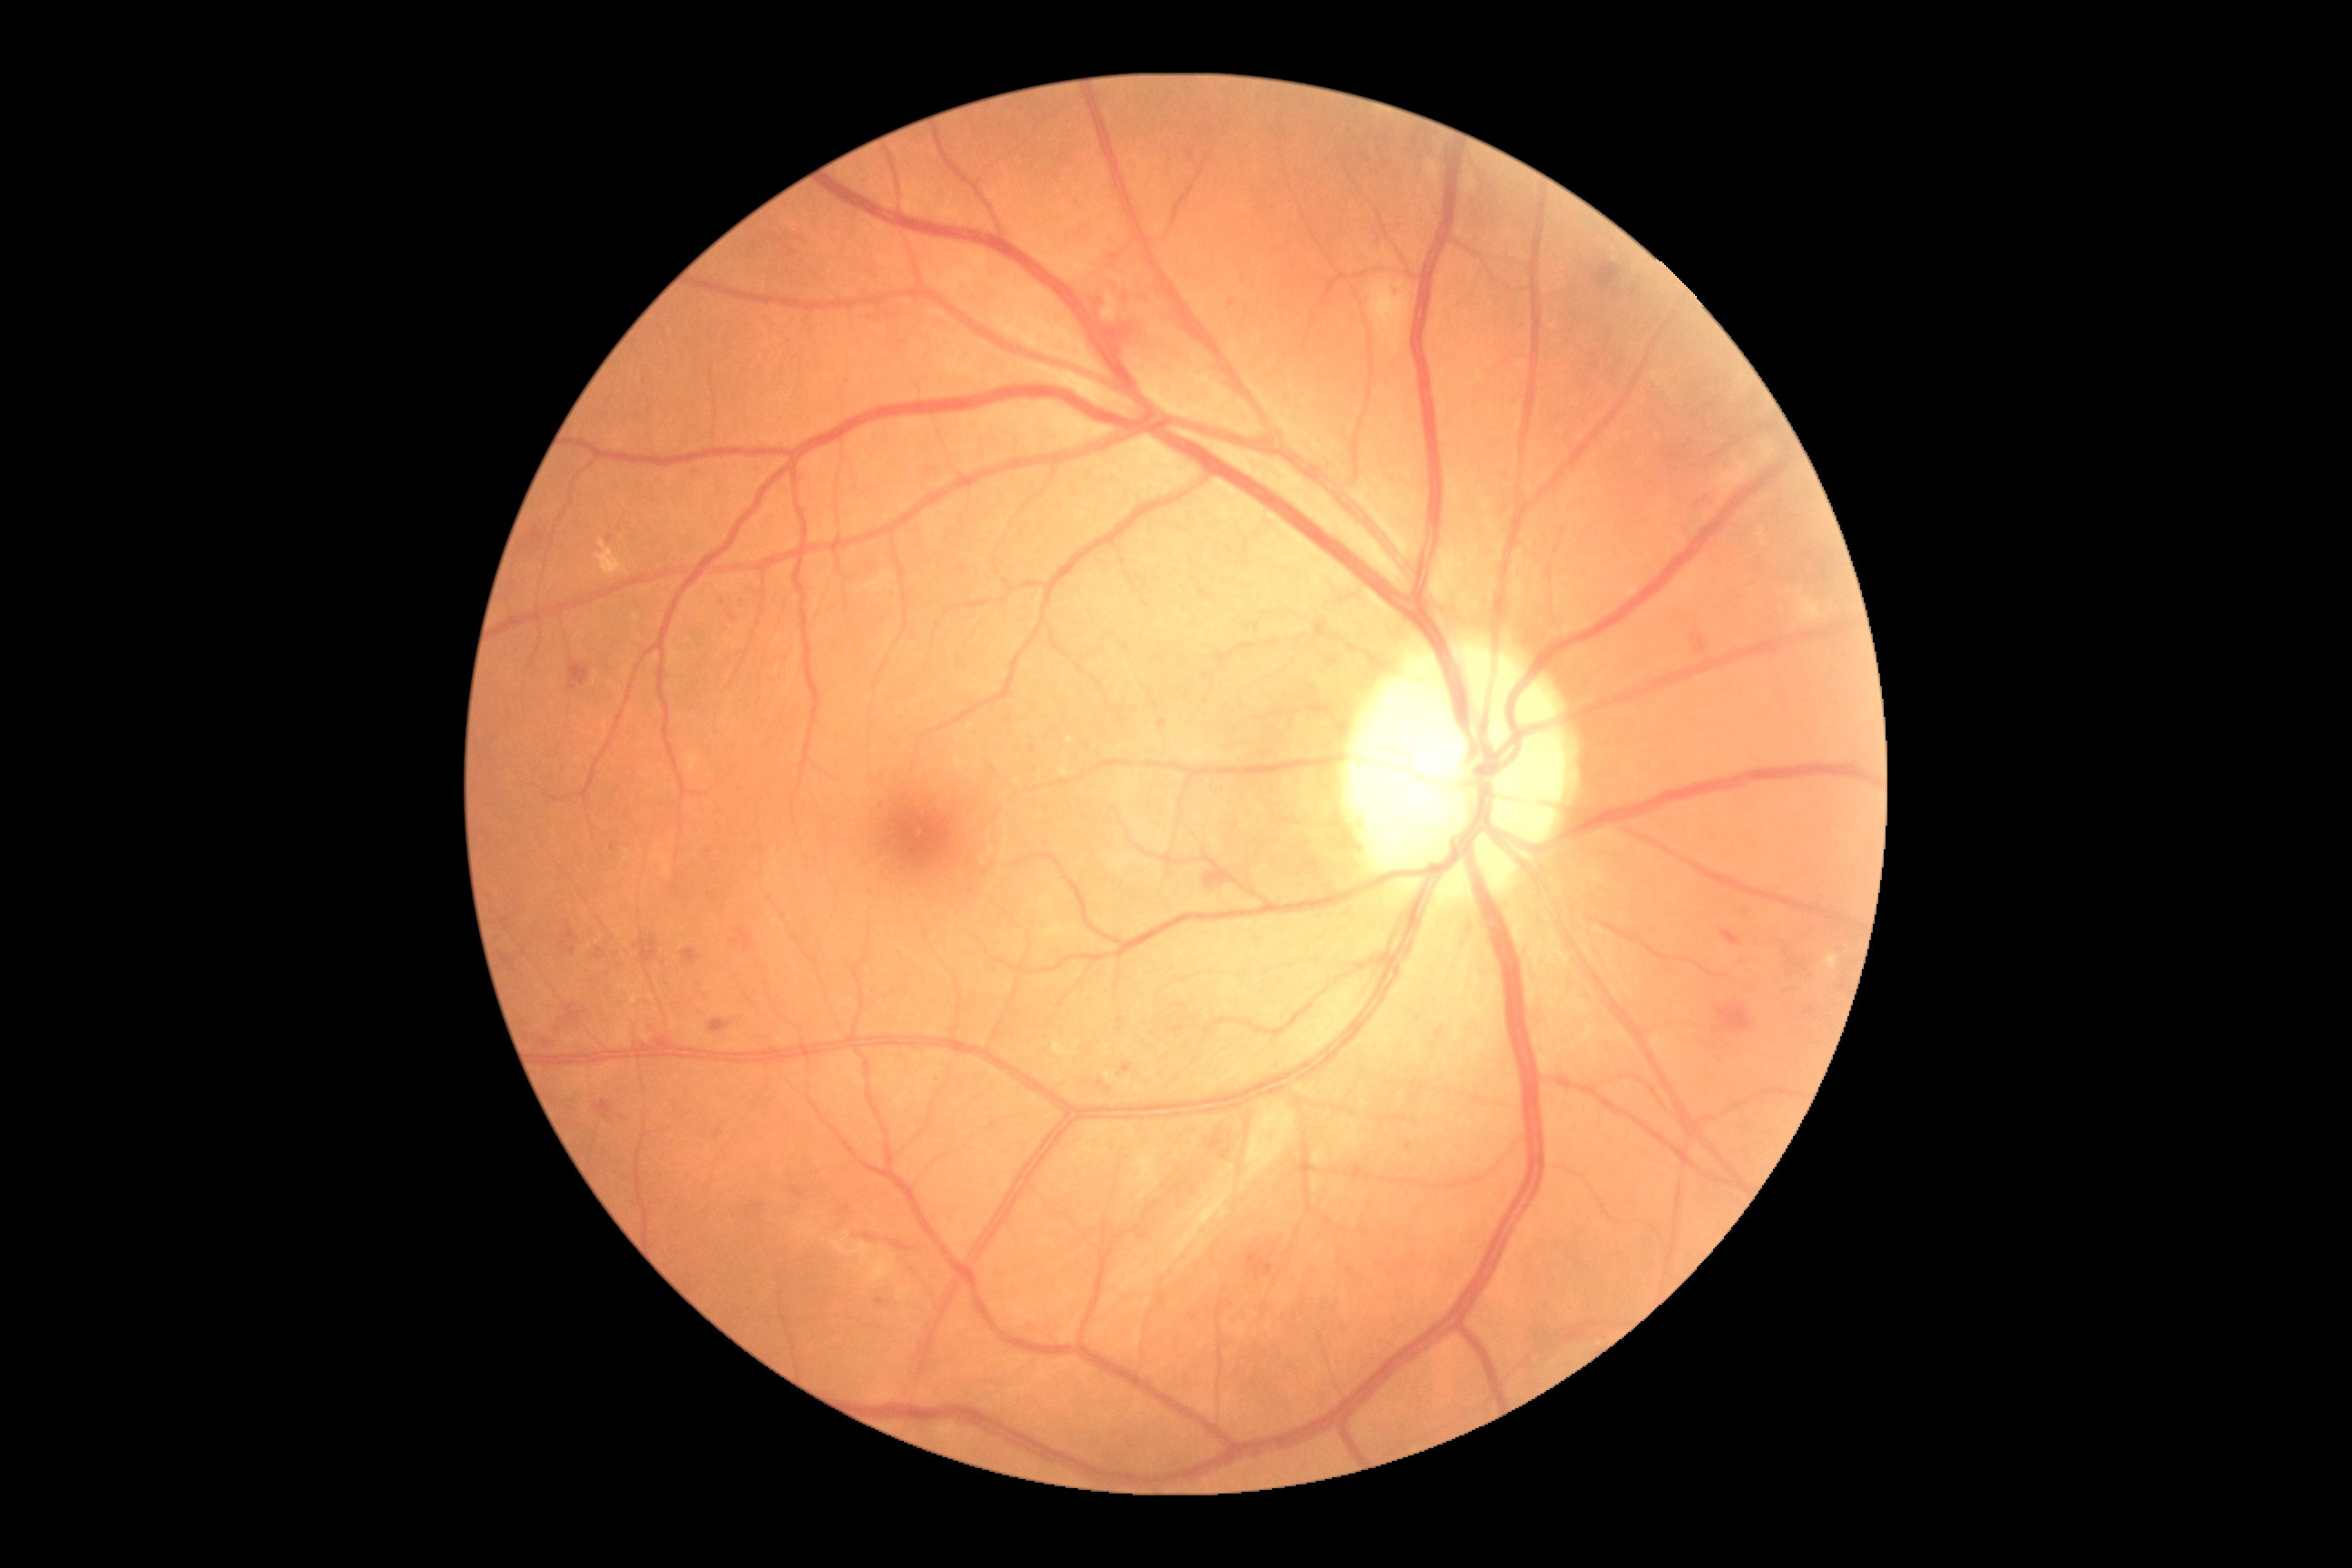
Diabetic retinopathy (DR): grade 2.